45° FOV, CFP
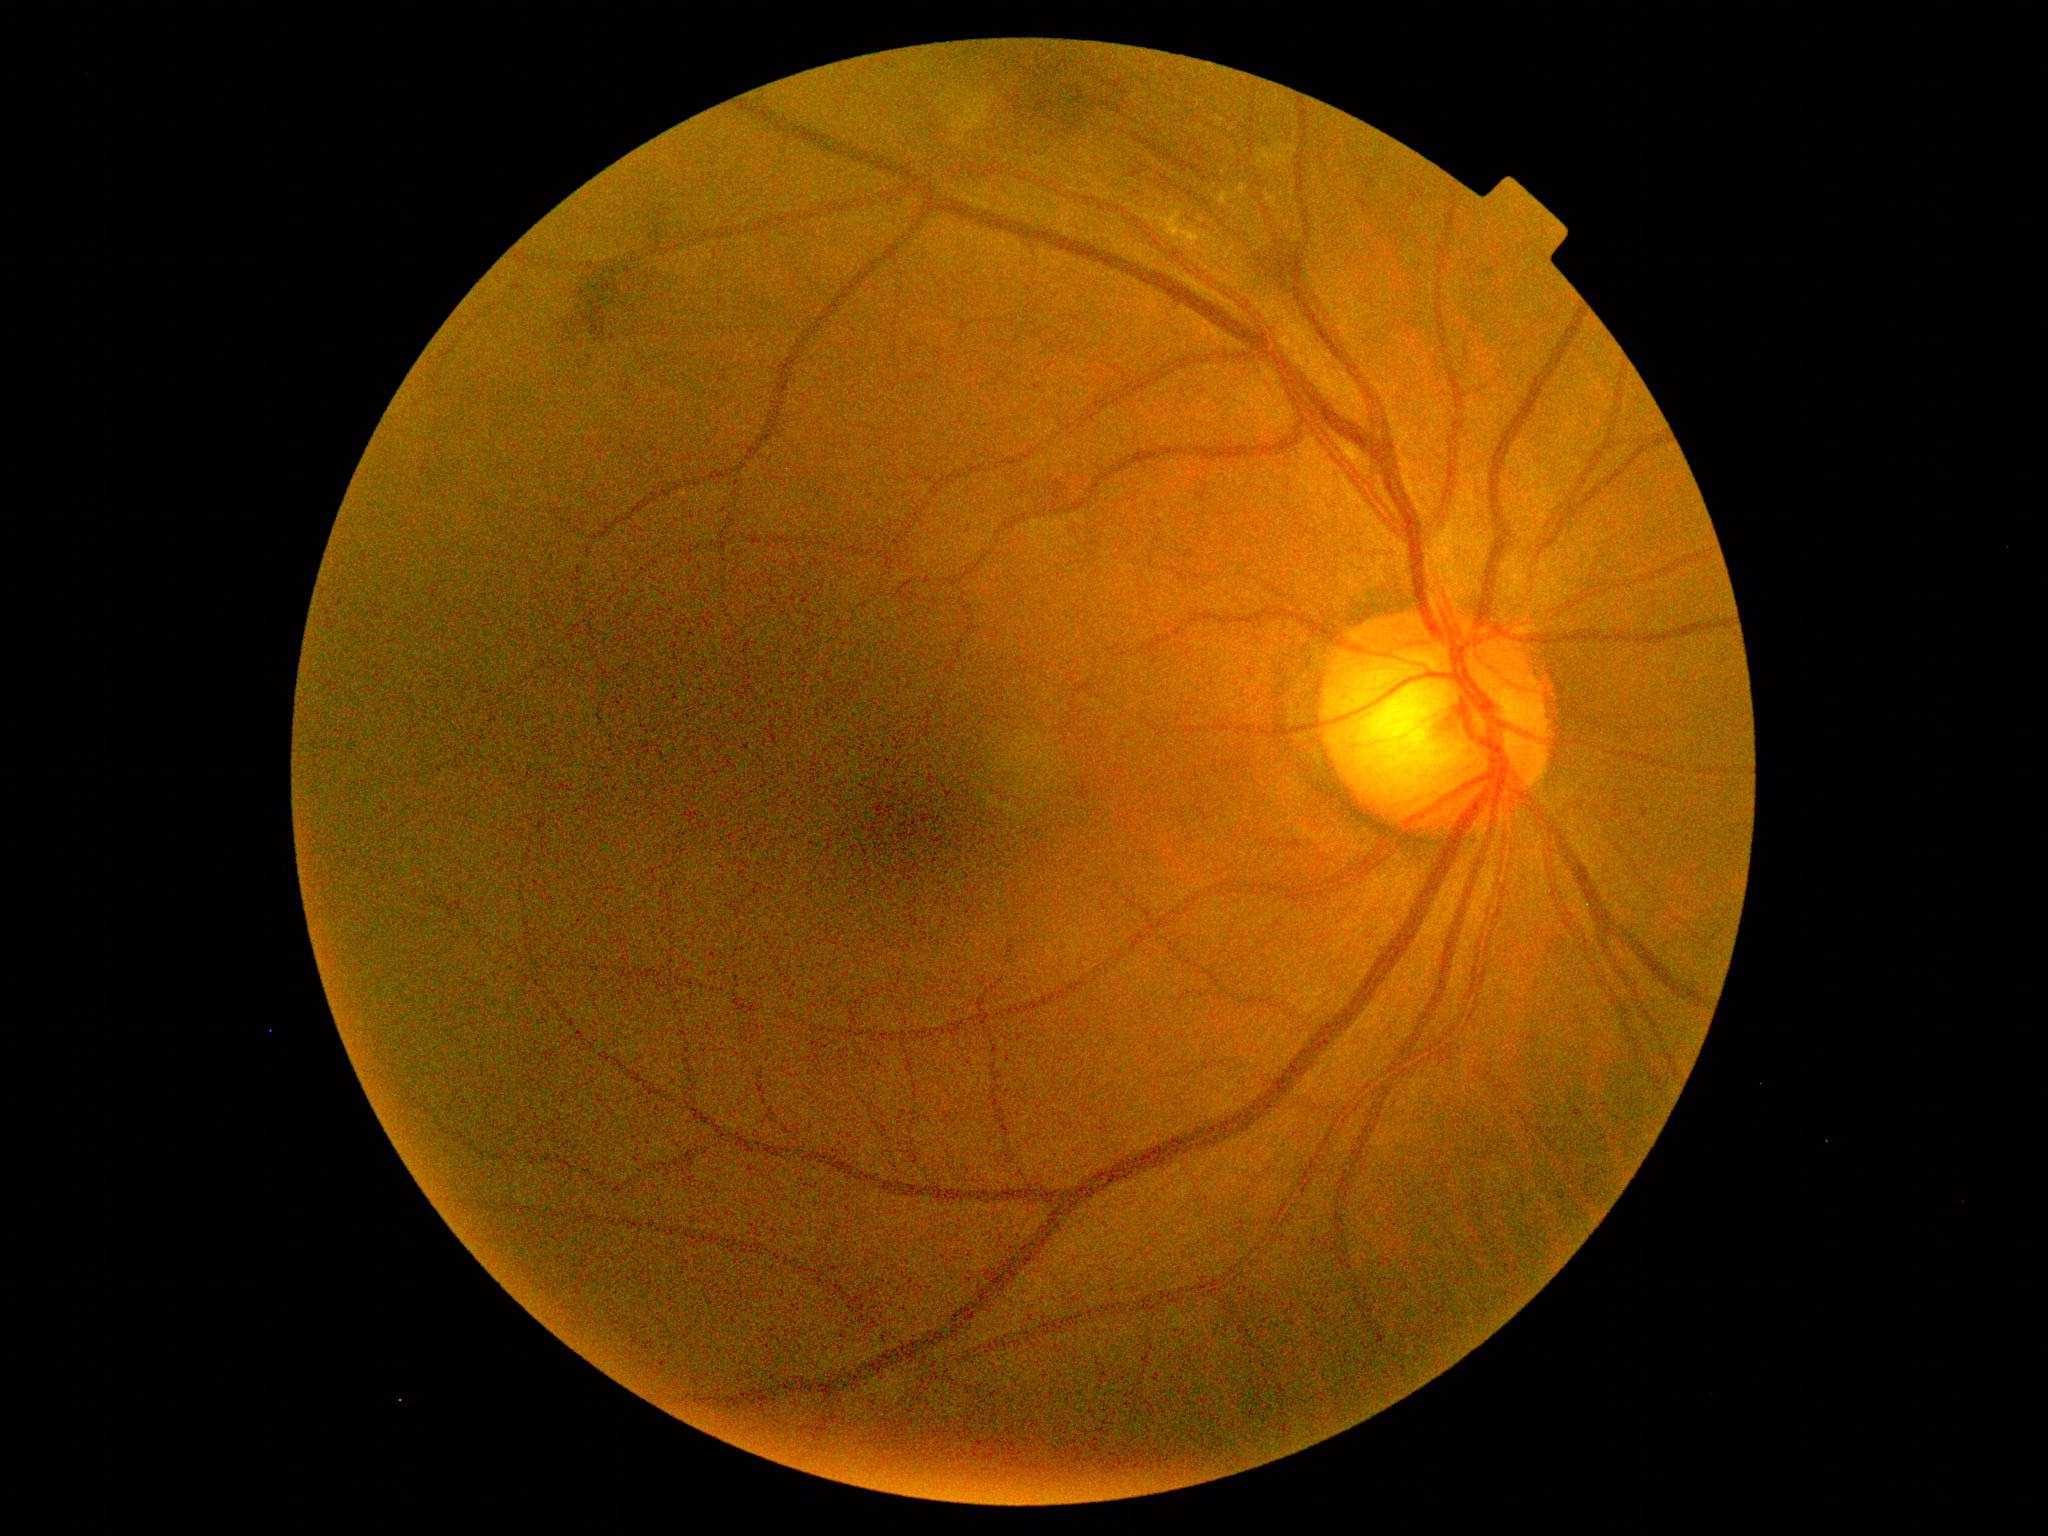

Retinopathy grade is moderate NPDR (2).